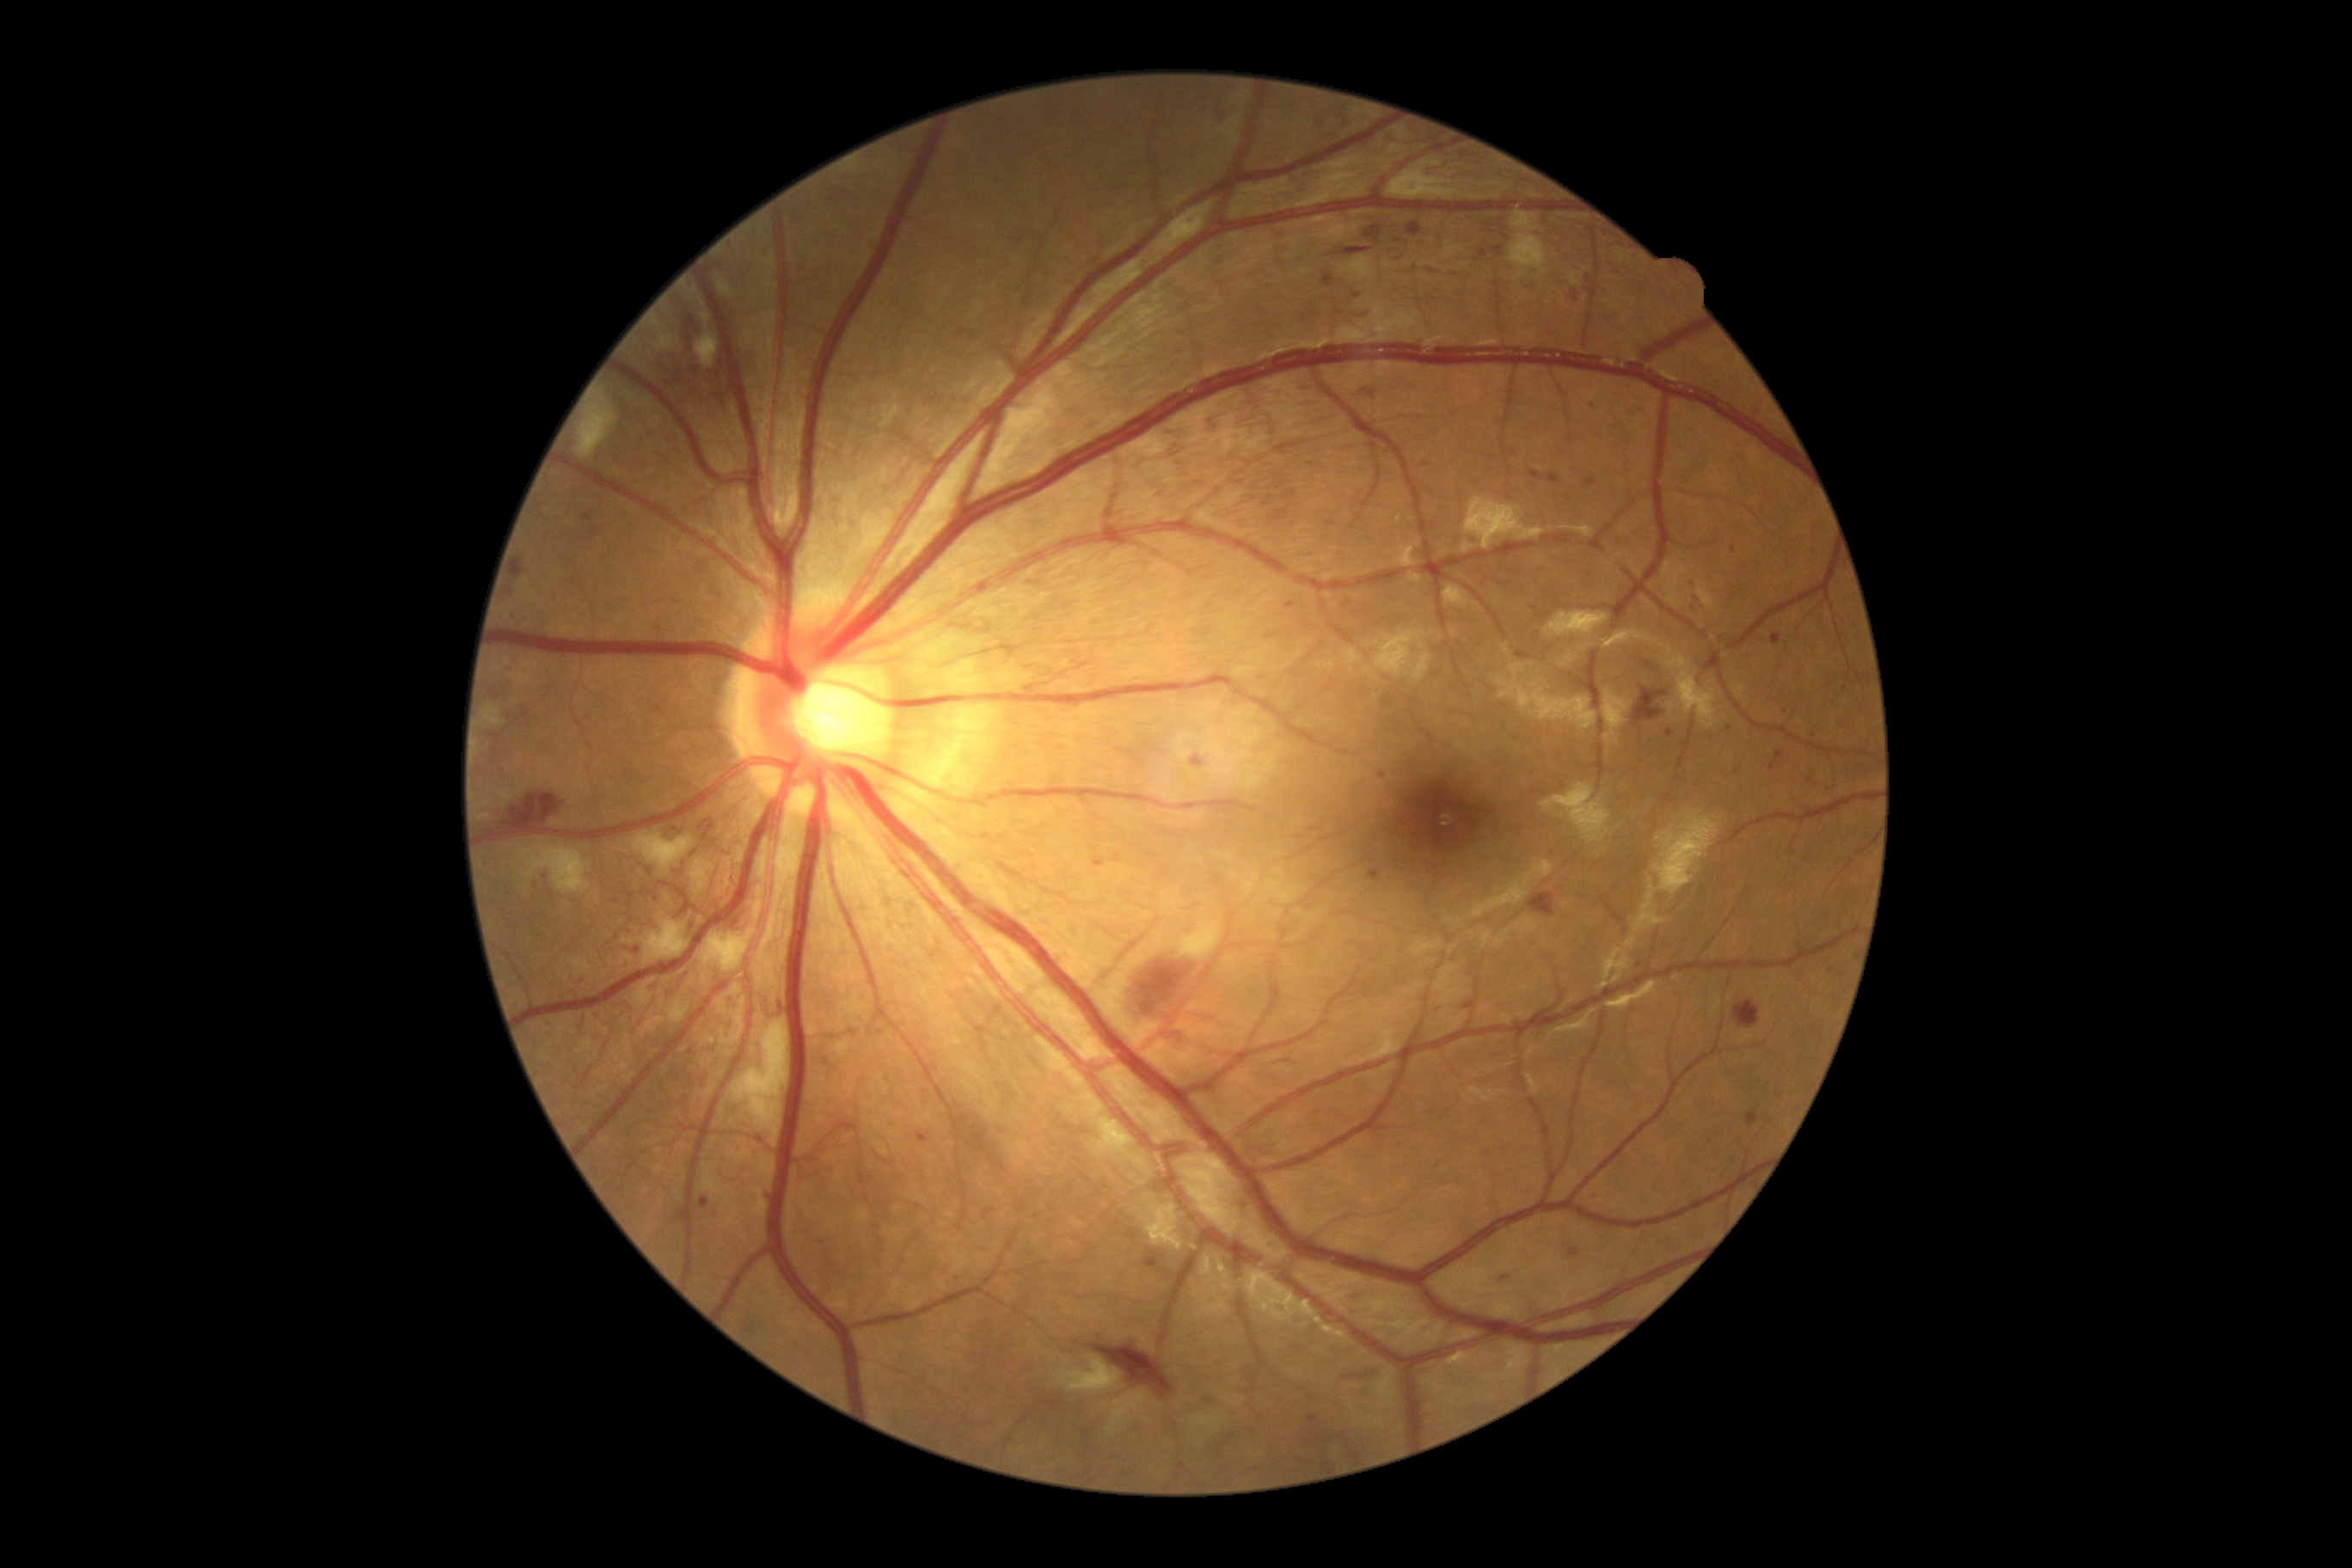
Diabetic retinopathy severity: grade 3 (severe NPDR); non-proliferative diabetic retinopathy
Lesions identified (partial list):
hemorrhages (partial): (left=1368, top=871, right=1381, bottom=881), (left=984, top=1210, right=996, bottom=1218), (left=1734, top=1001, right=1760, bottom=1027), (left=1768, top=792, right=1779, bottom=800), (left=1235, top=481, right=1244, bottom=486), (left=505, top=793, right=567, bottom=835), (left=1491, top=247, right=1505, bottom=259), (left=689, top=281, right=695, bottom=290), (left=505, top=584, right=517, bottom=599), (left=1407, top=224, right=1423, bottom=236), (left=1094, top=859, right=1105, bottom=867), (left=1474, top=247, right=1488, bottom=262), (left=1715, top=634, right=1734, bottom=647), (left=1337, top=113, right=1354, bottom=130), (left=701, top=1196, right=709, bottom=1210)
Small hemorrhages approximately at (x=1198, y=484), (x=510, y=895), (x=1400, y=241), (x=1733, y=550)